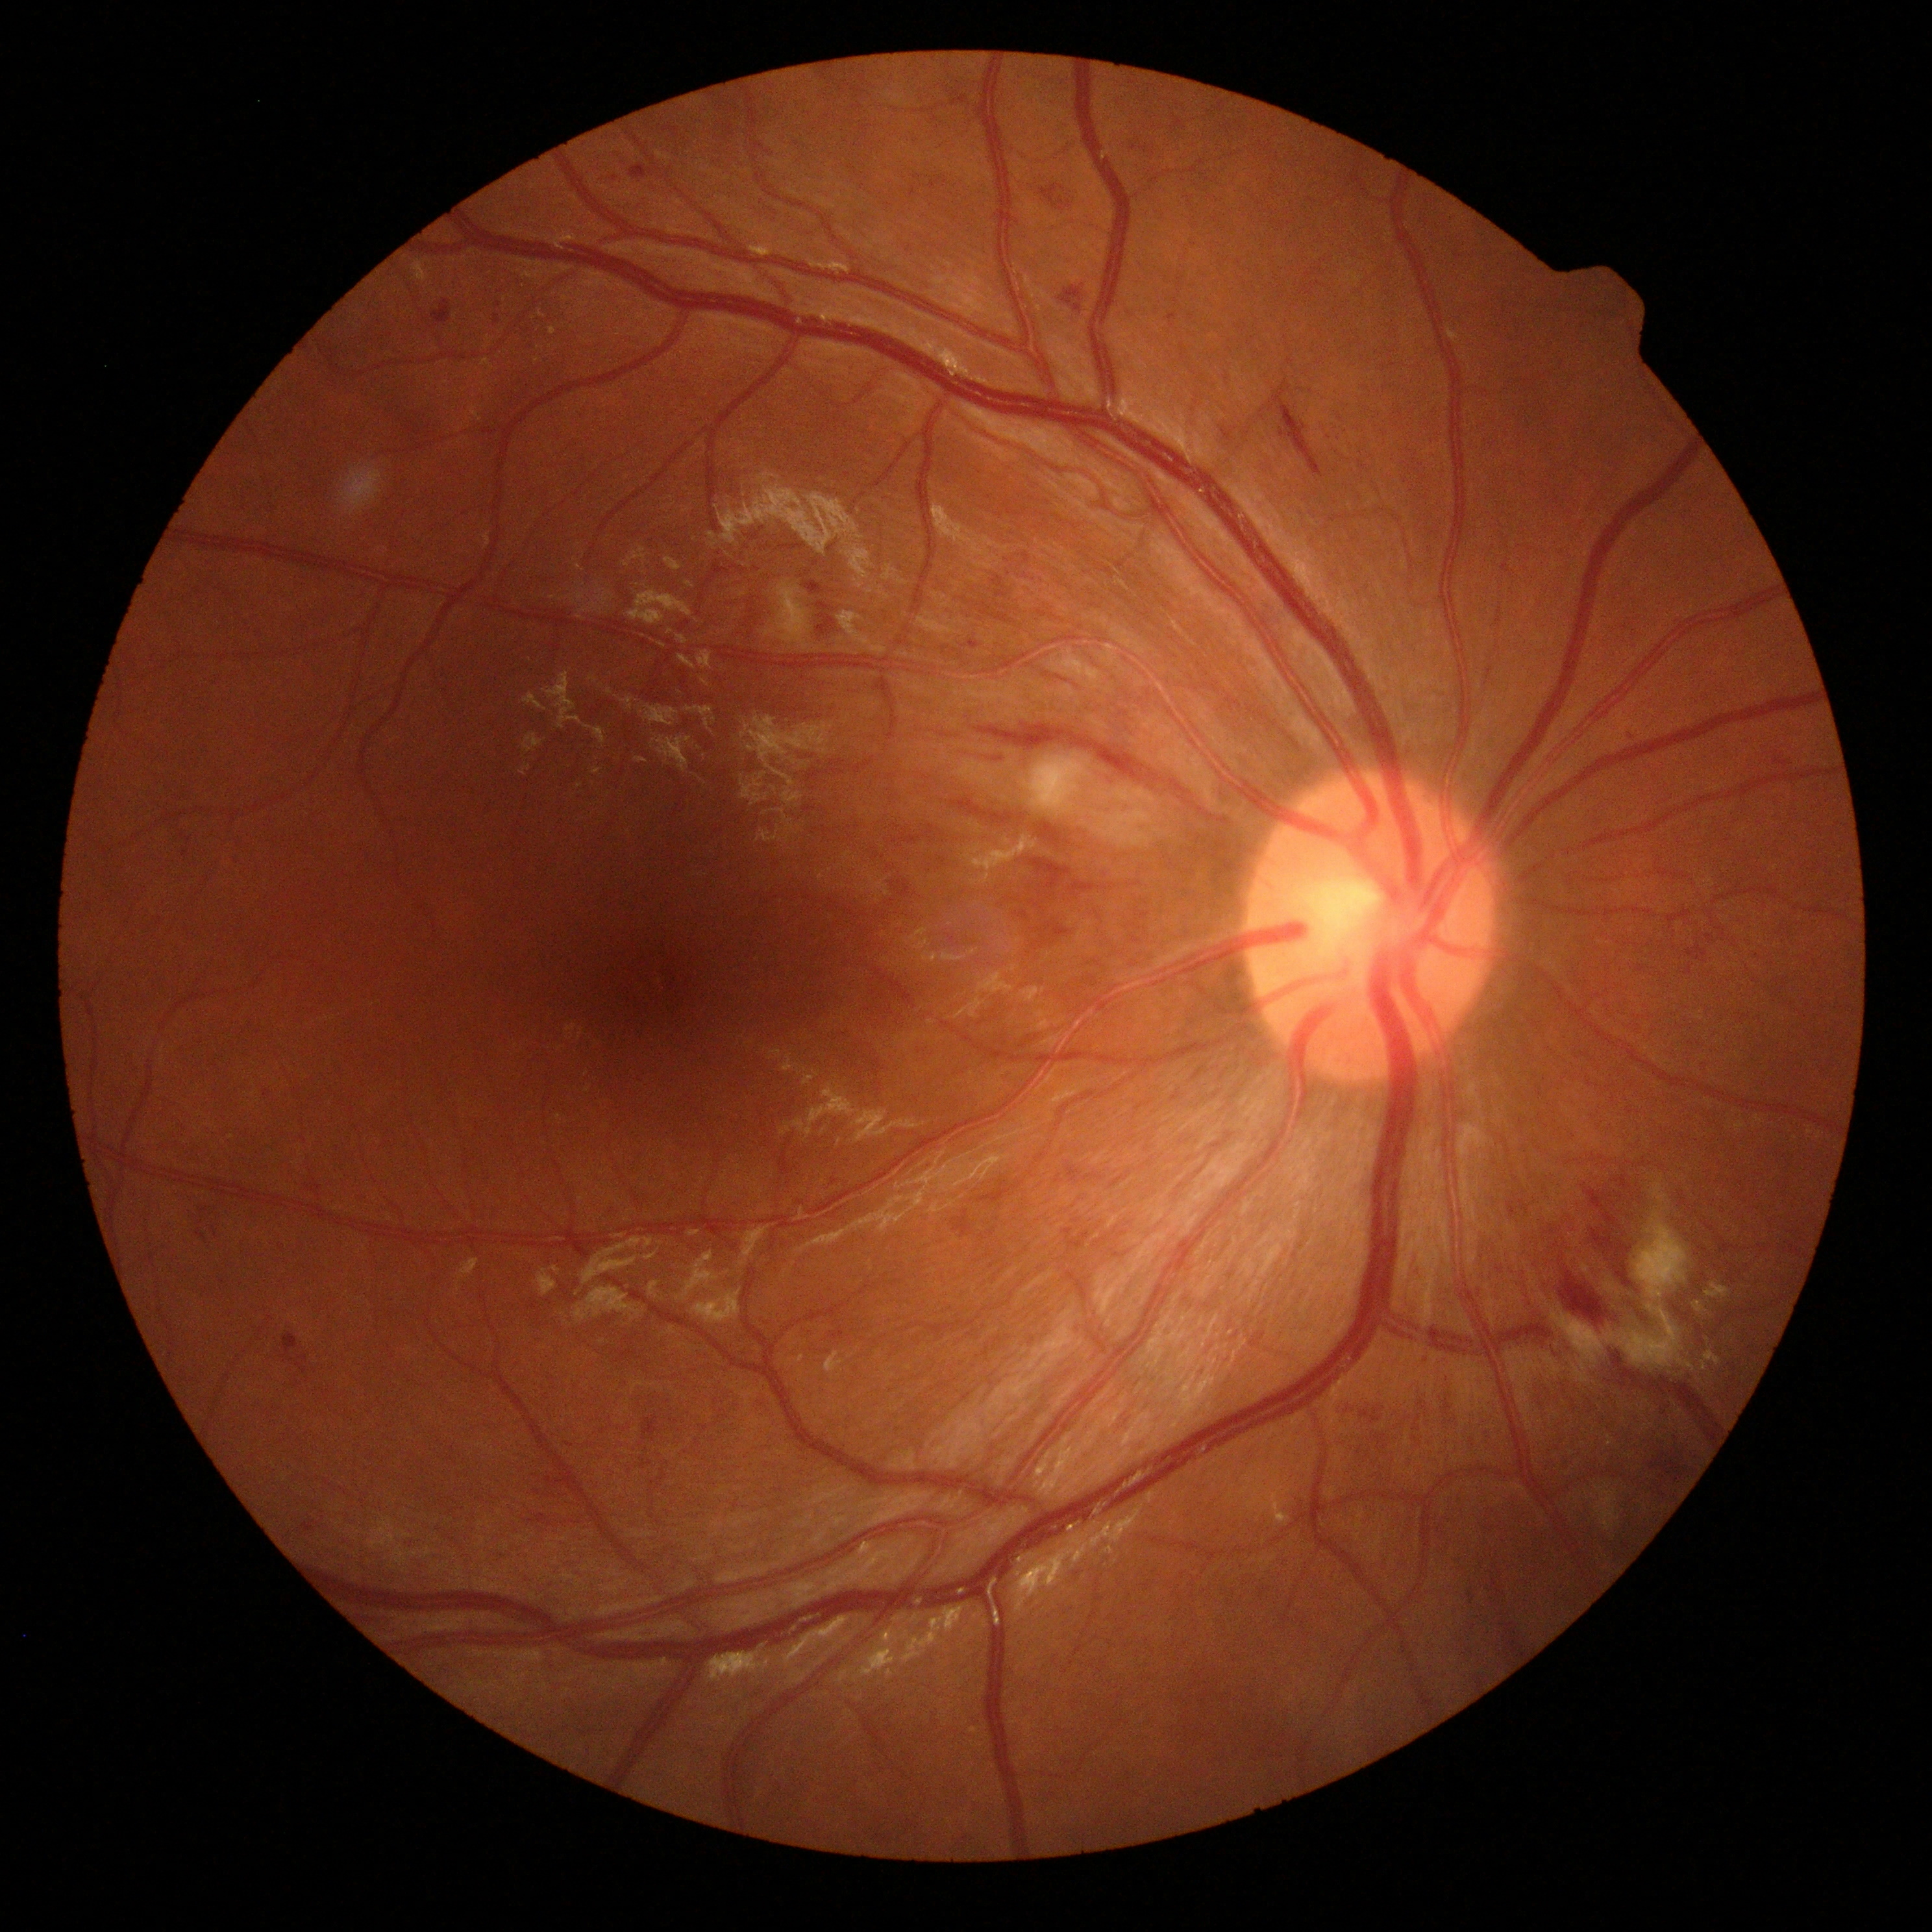

{"dr_grade": "grade 2 (moderate NPDR) — more than just microaneurysms but less than severe NPDR"}